Retinal fundus photograph. Nonmydriatic:
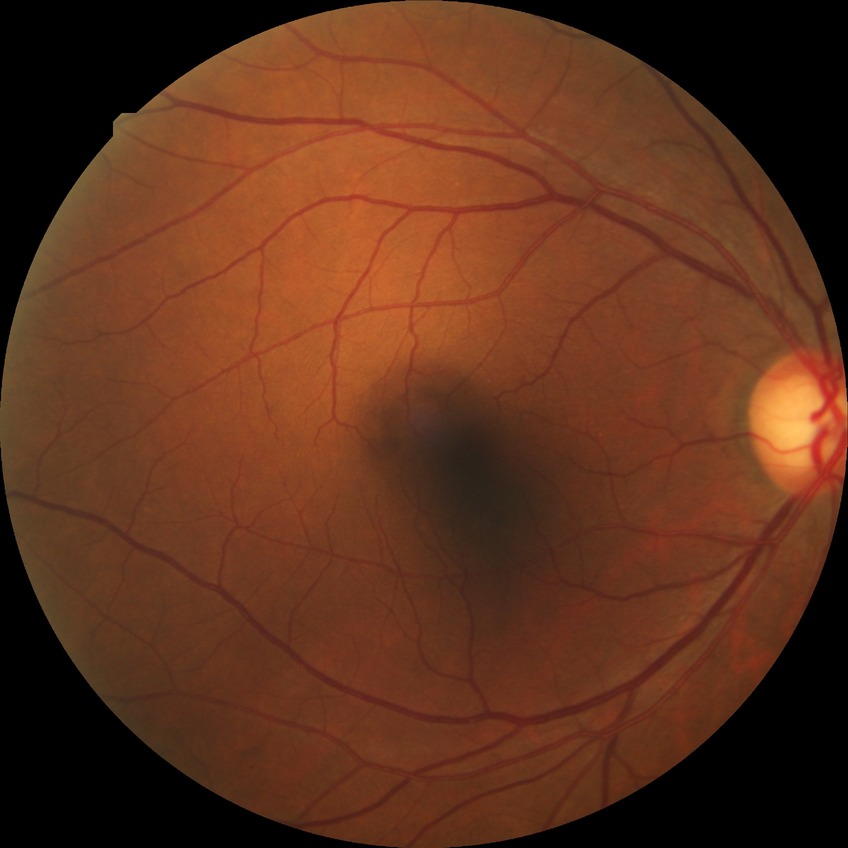

Diabetic retinopathy (DR): simple diabetic retinopathy (SDR).